Davis DR grading; without pupil dilation; 45-degree field of view; color fundus image
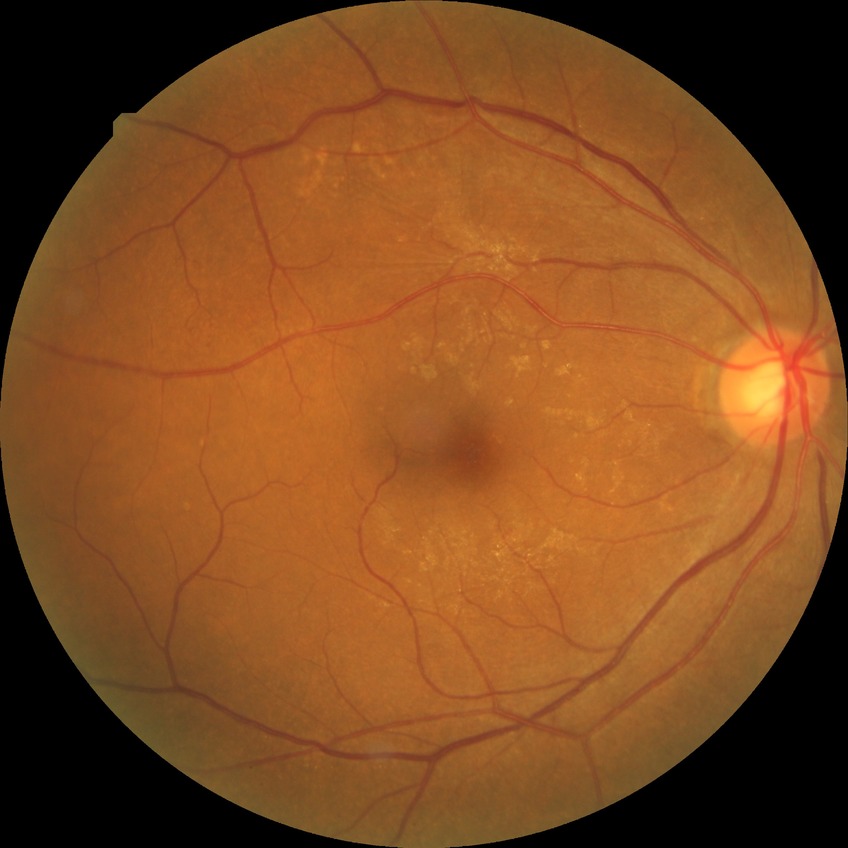

Diabetic retinopathy grade is simple diabetic retinopathy.